45-degree field of view — 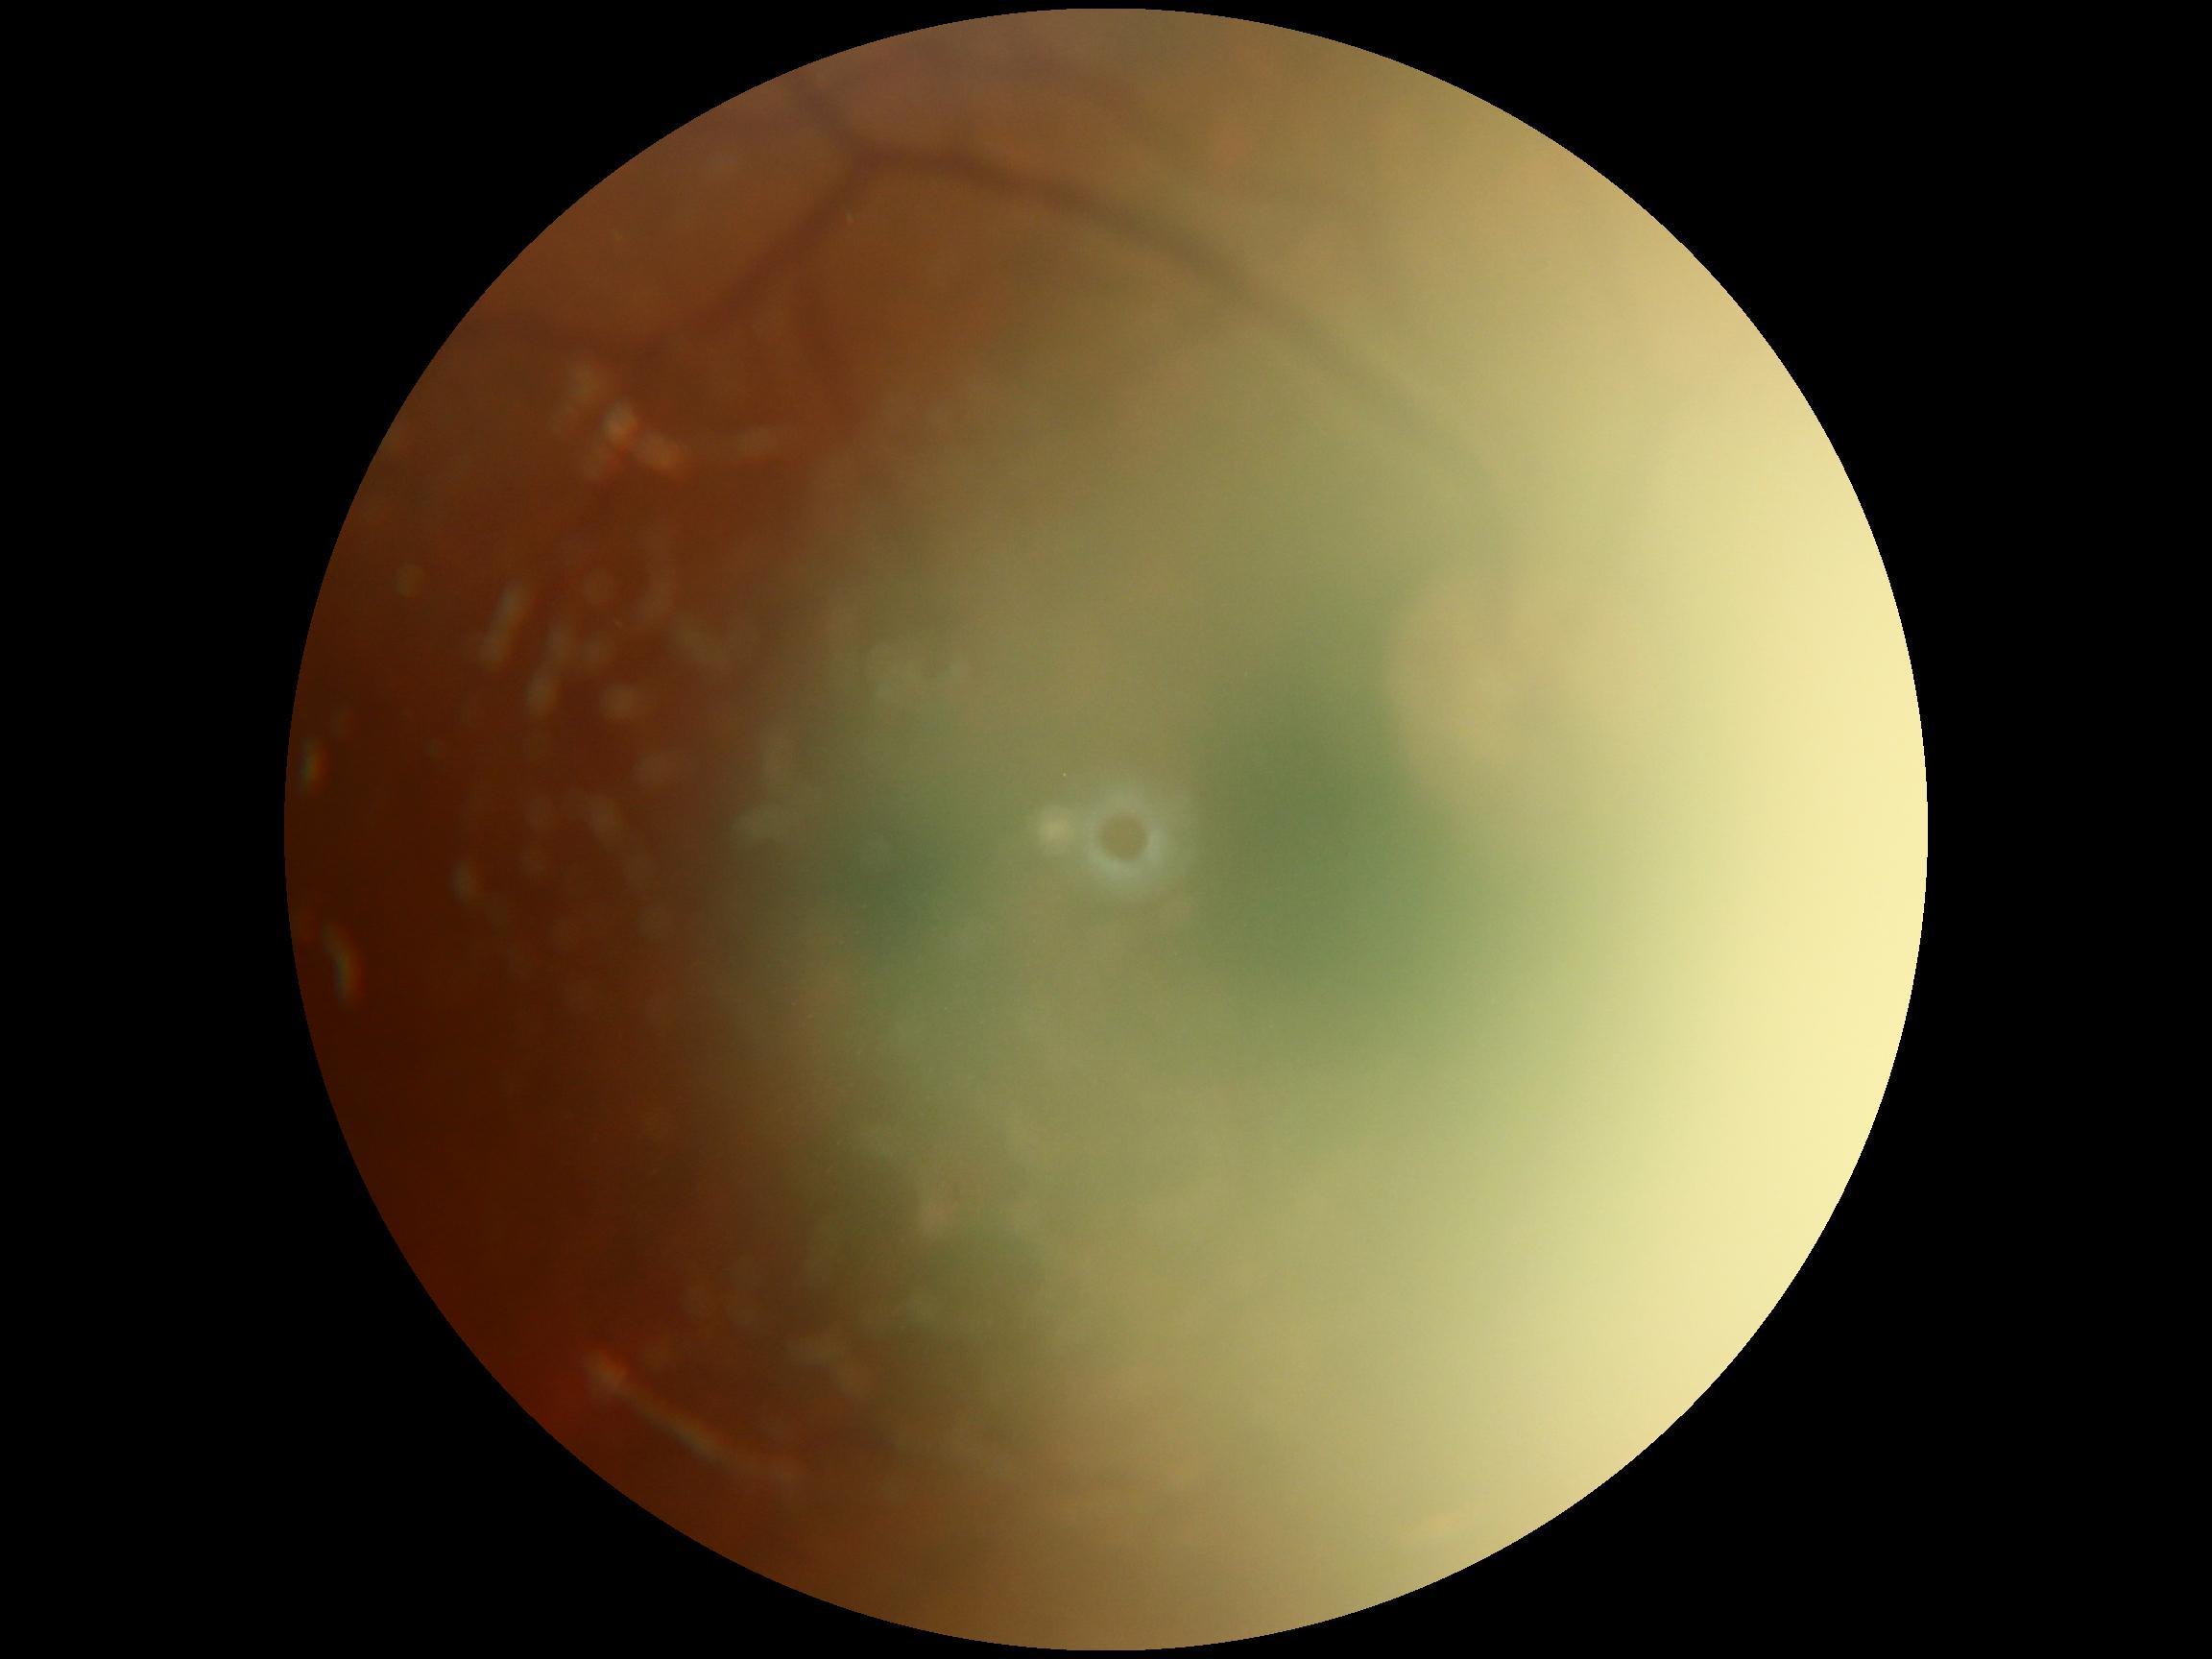 DR grade is ungradable. Quality too poor to assess for DR.